200-degree field of view · ultra-widefield (UWF) fundus image
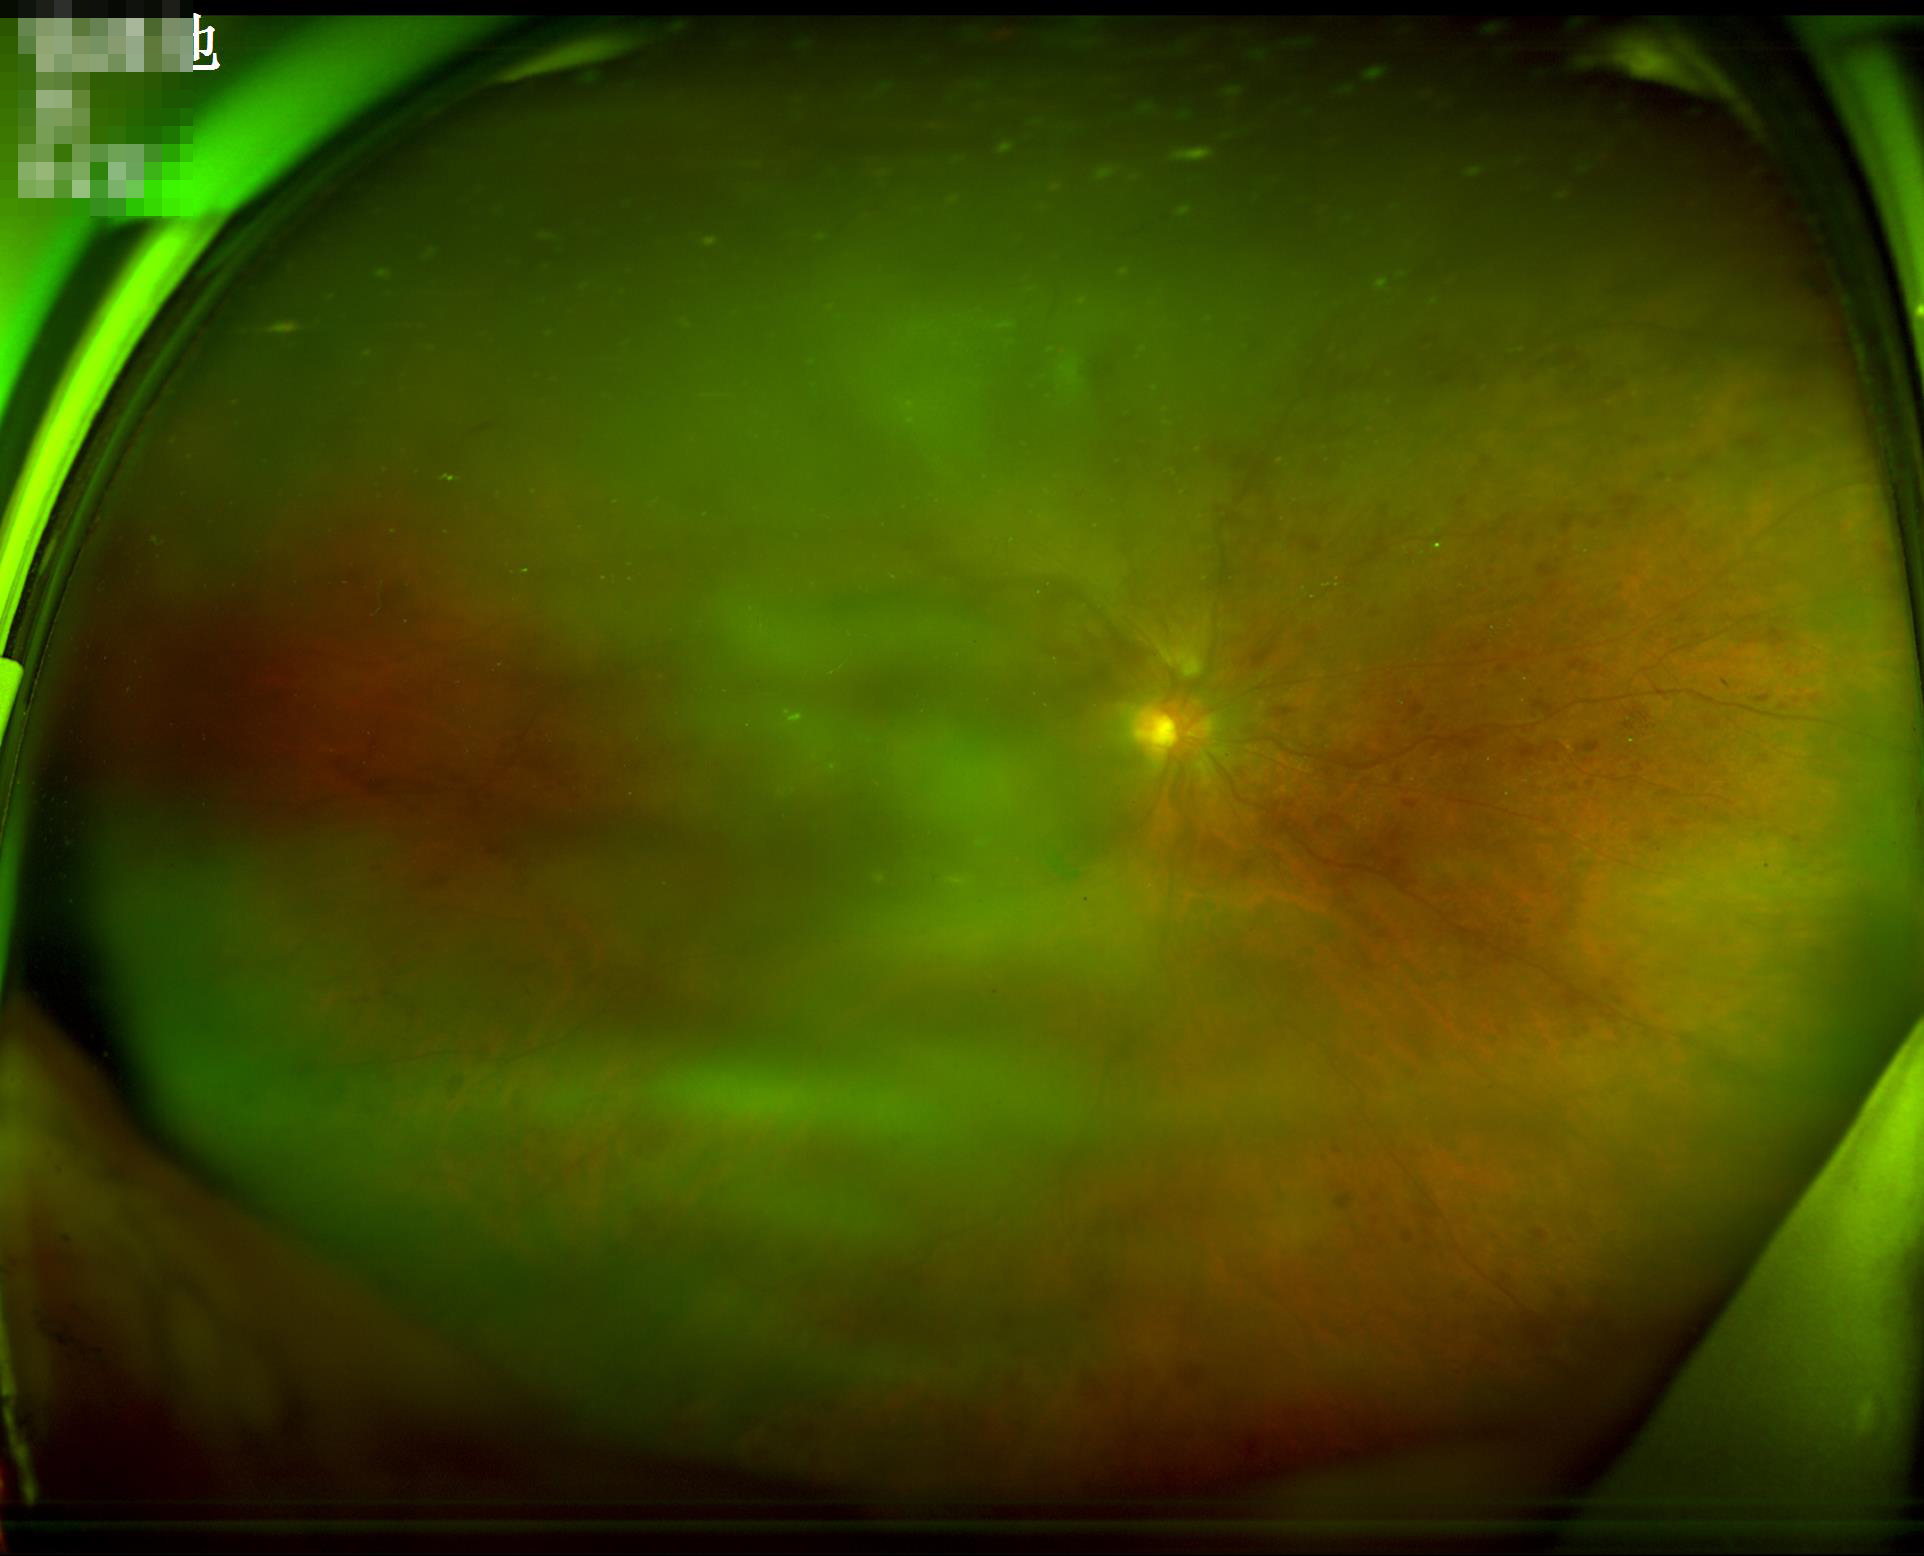

Reduced sharpness with visible blur. Narrow intensity range; structures are hard to distinguish. Illumination is uneven. Overall image quality is poor.